Modified Davis classification, 45° field of view, nonmydriatic fundus photograph: 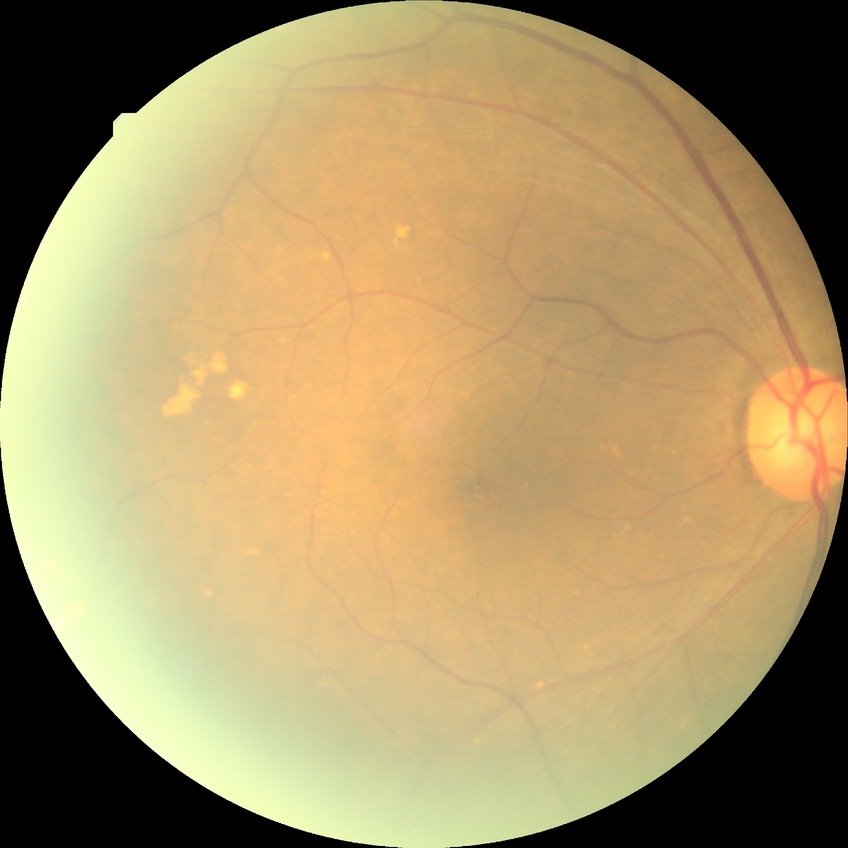
diabetic retinopathy (DR): NDR (no diabetic retinopathy).